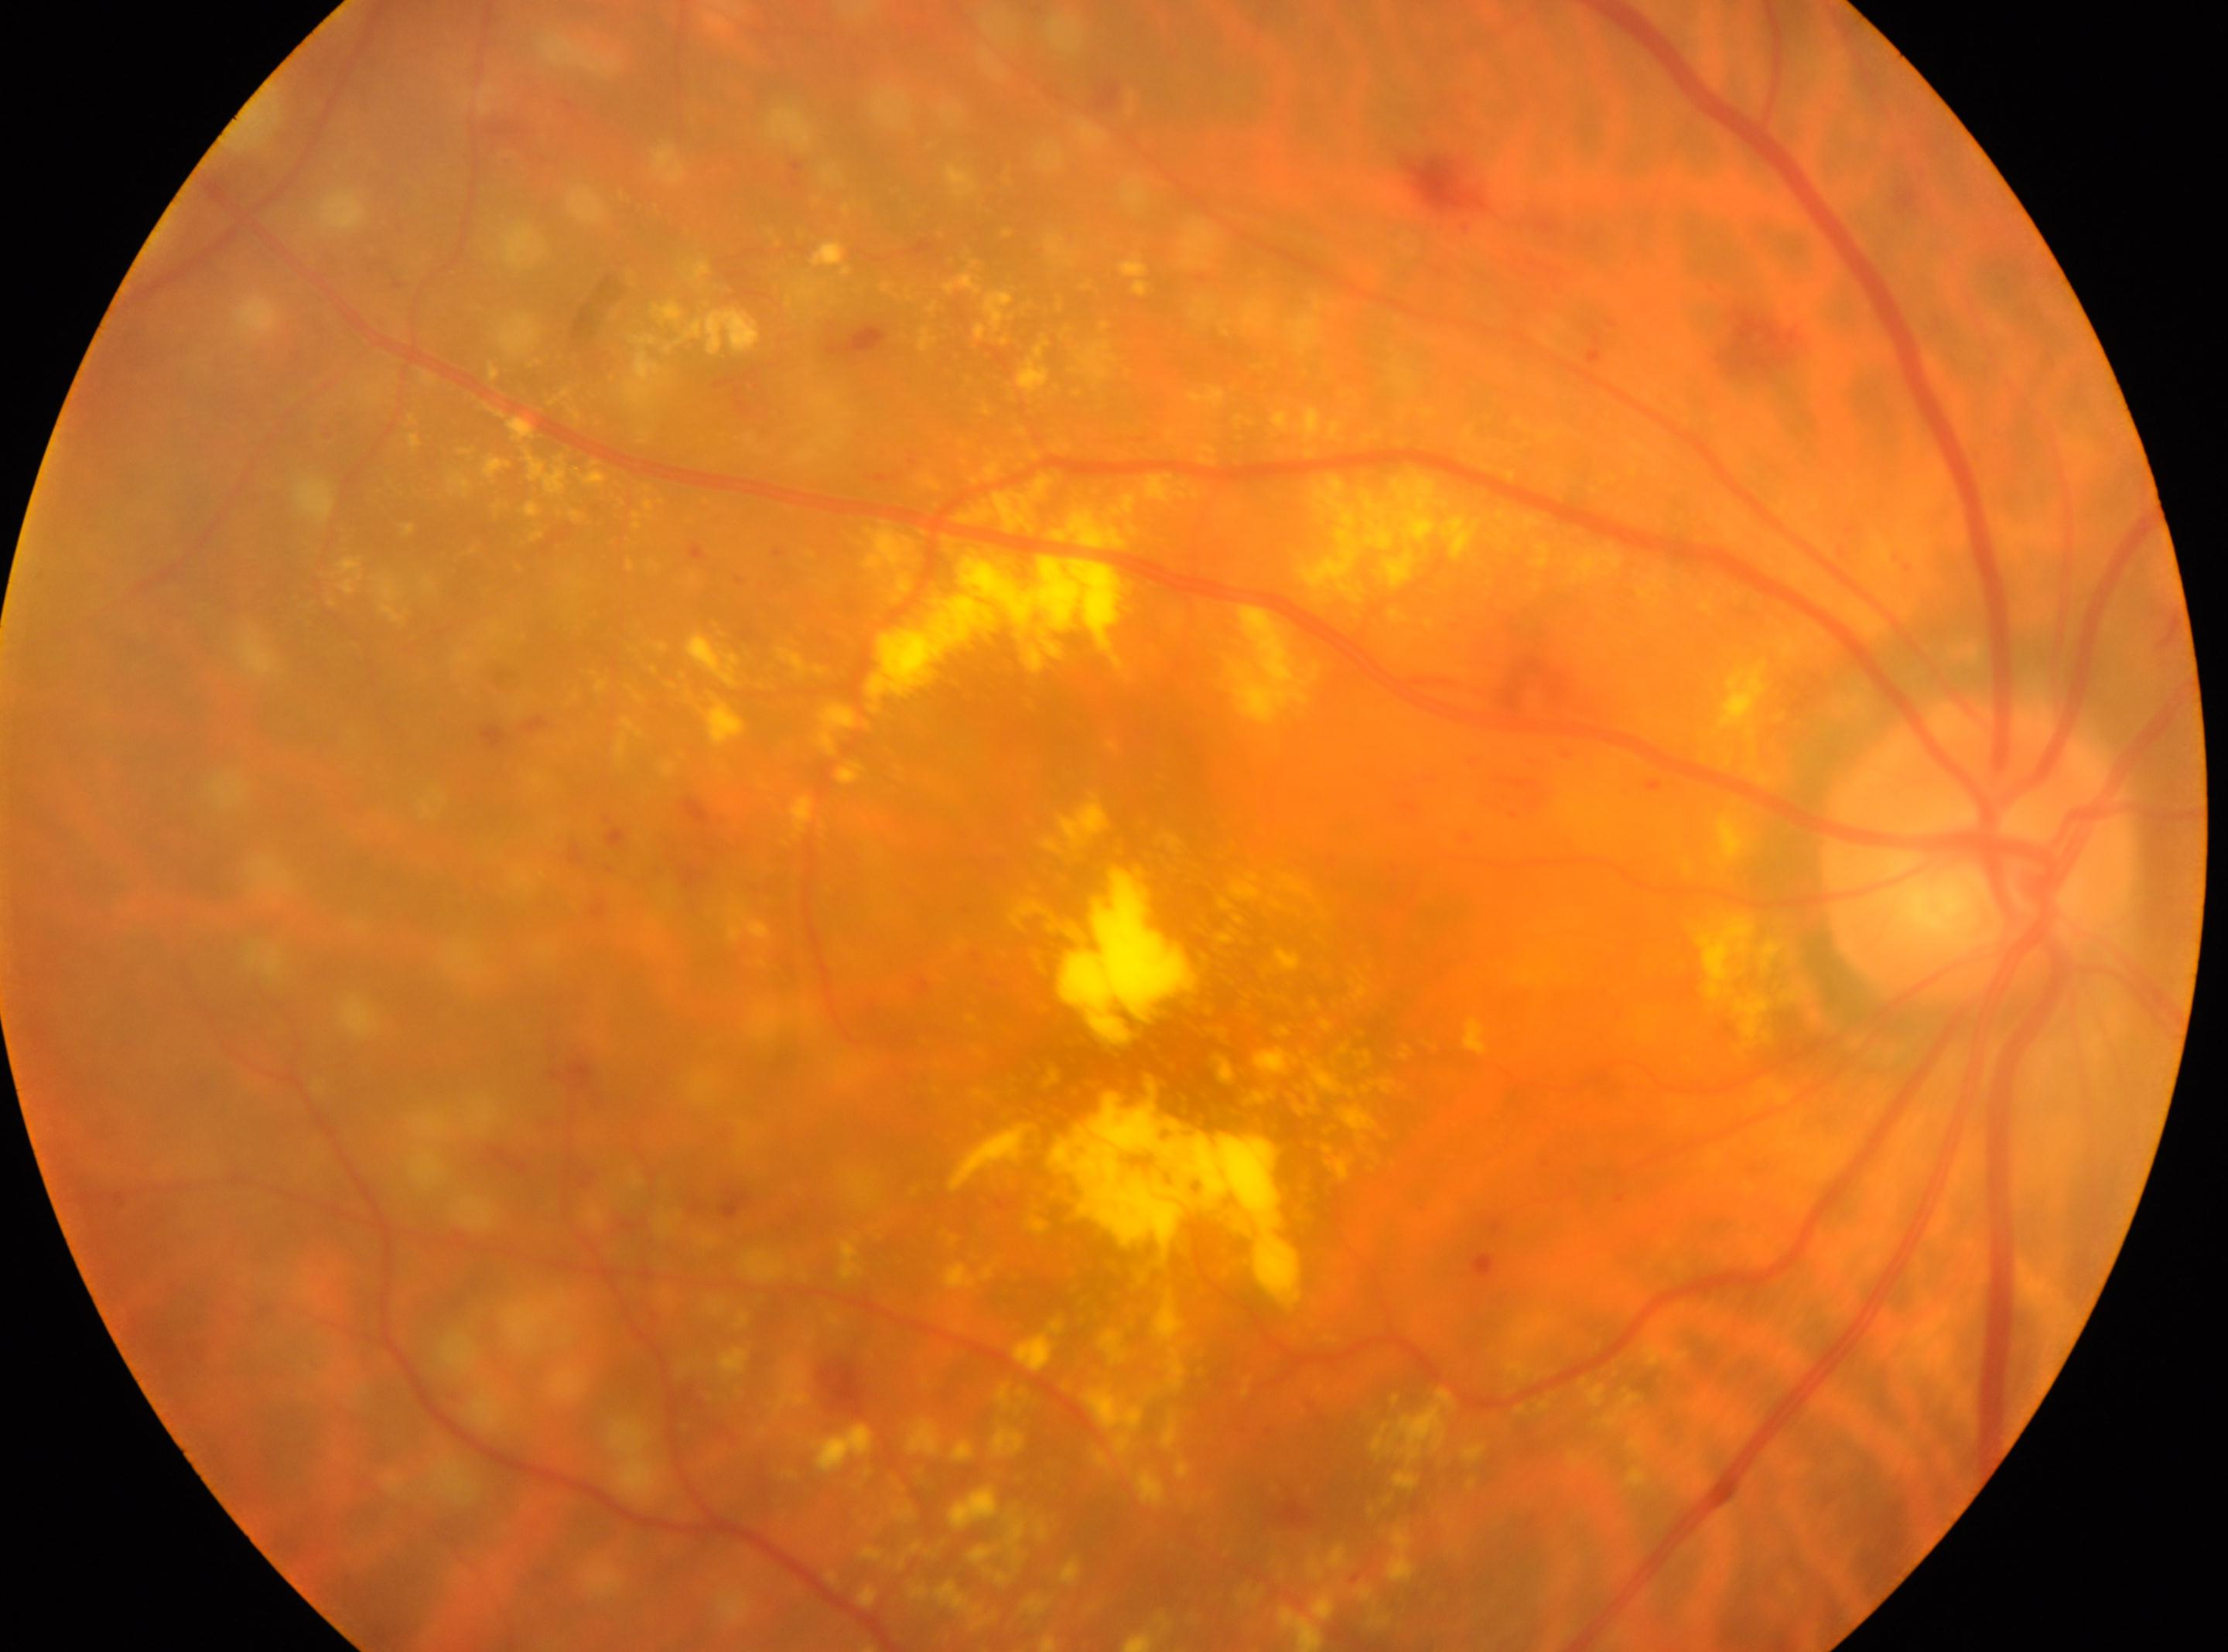

Optic disk located at 1976px, 855px. Diabetic retinopathy is post-laser DR, reclassified as moderate NPDR (grade 2). This is the oculus dexter. Fovea centralis: 1167px, 1039px.